640 x 480 pixels · infant wide-field retinal image:
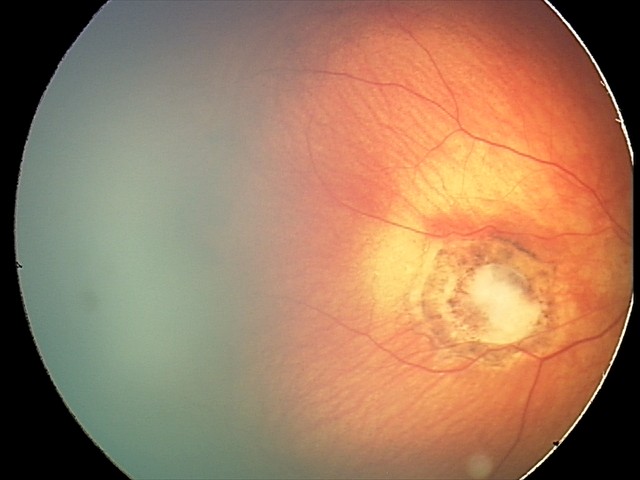
Screening diagnosis: toxoplasmosis chorioretinitis.